45° field of view. Color fundus image. Image size 2352x1568
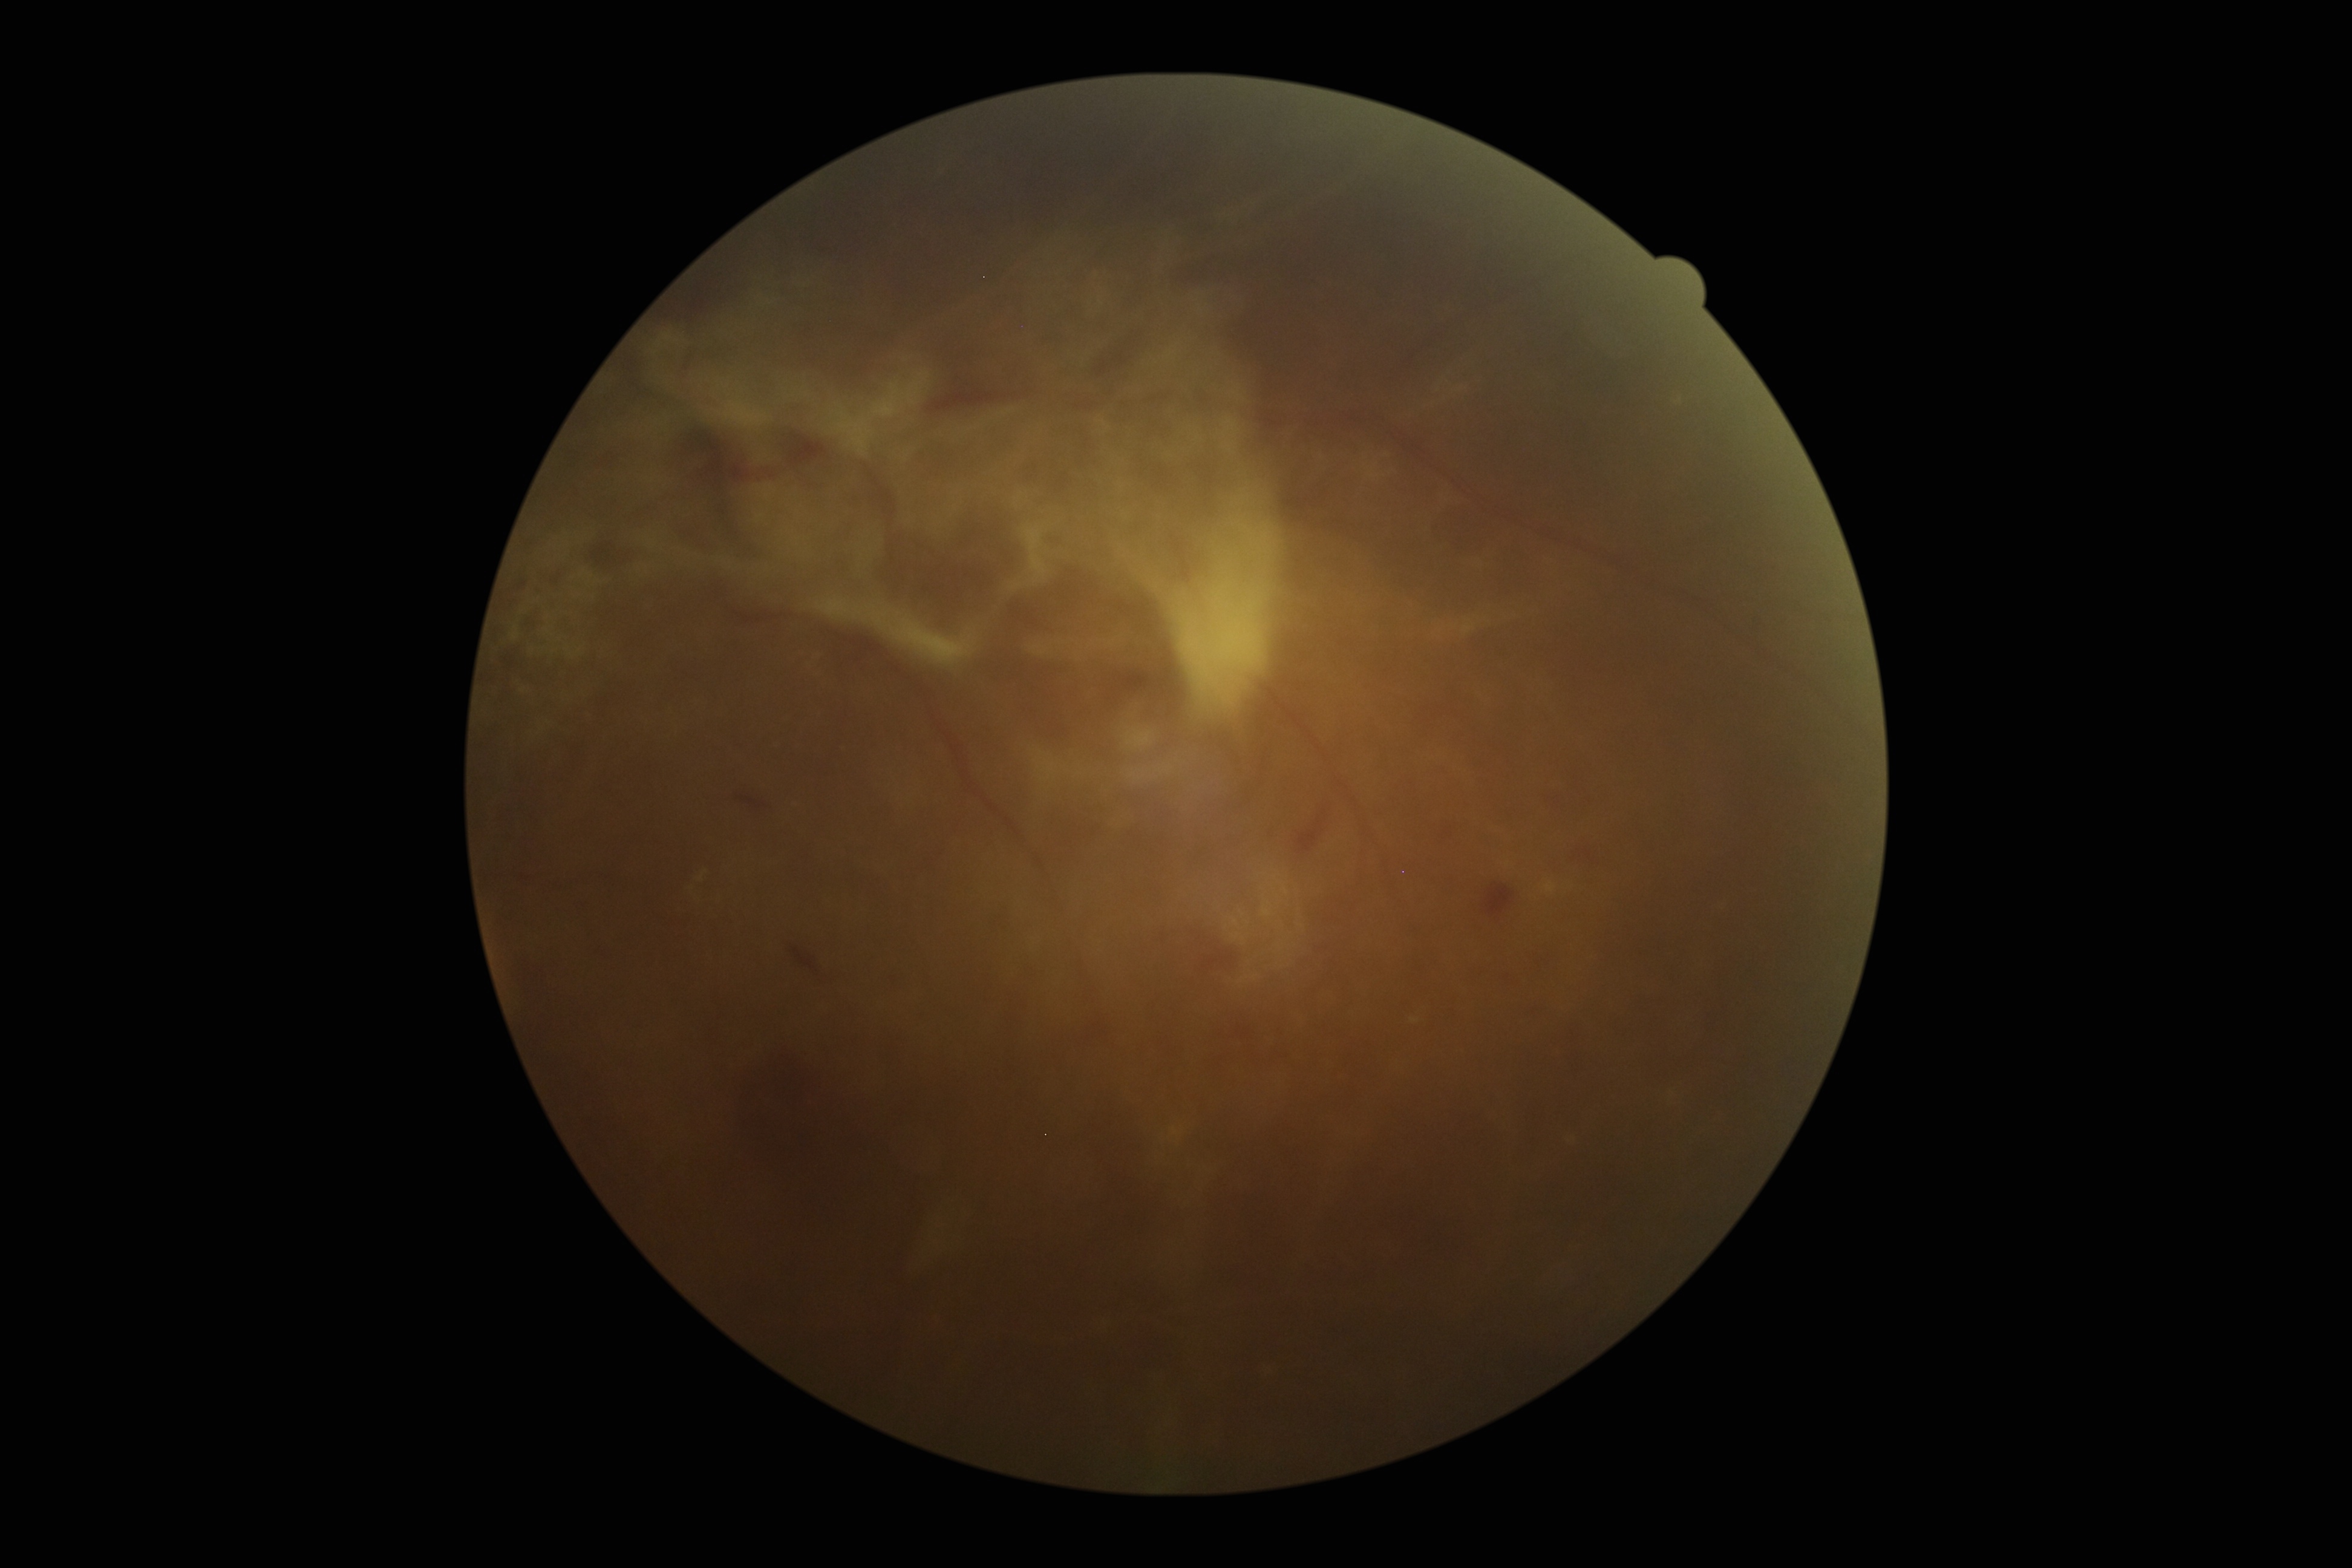

DR: grade 4 (PDR).